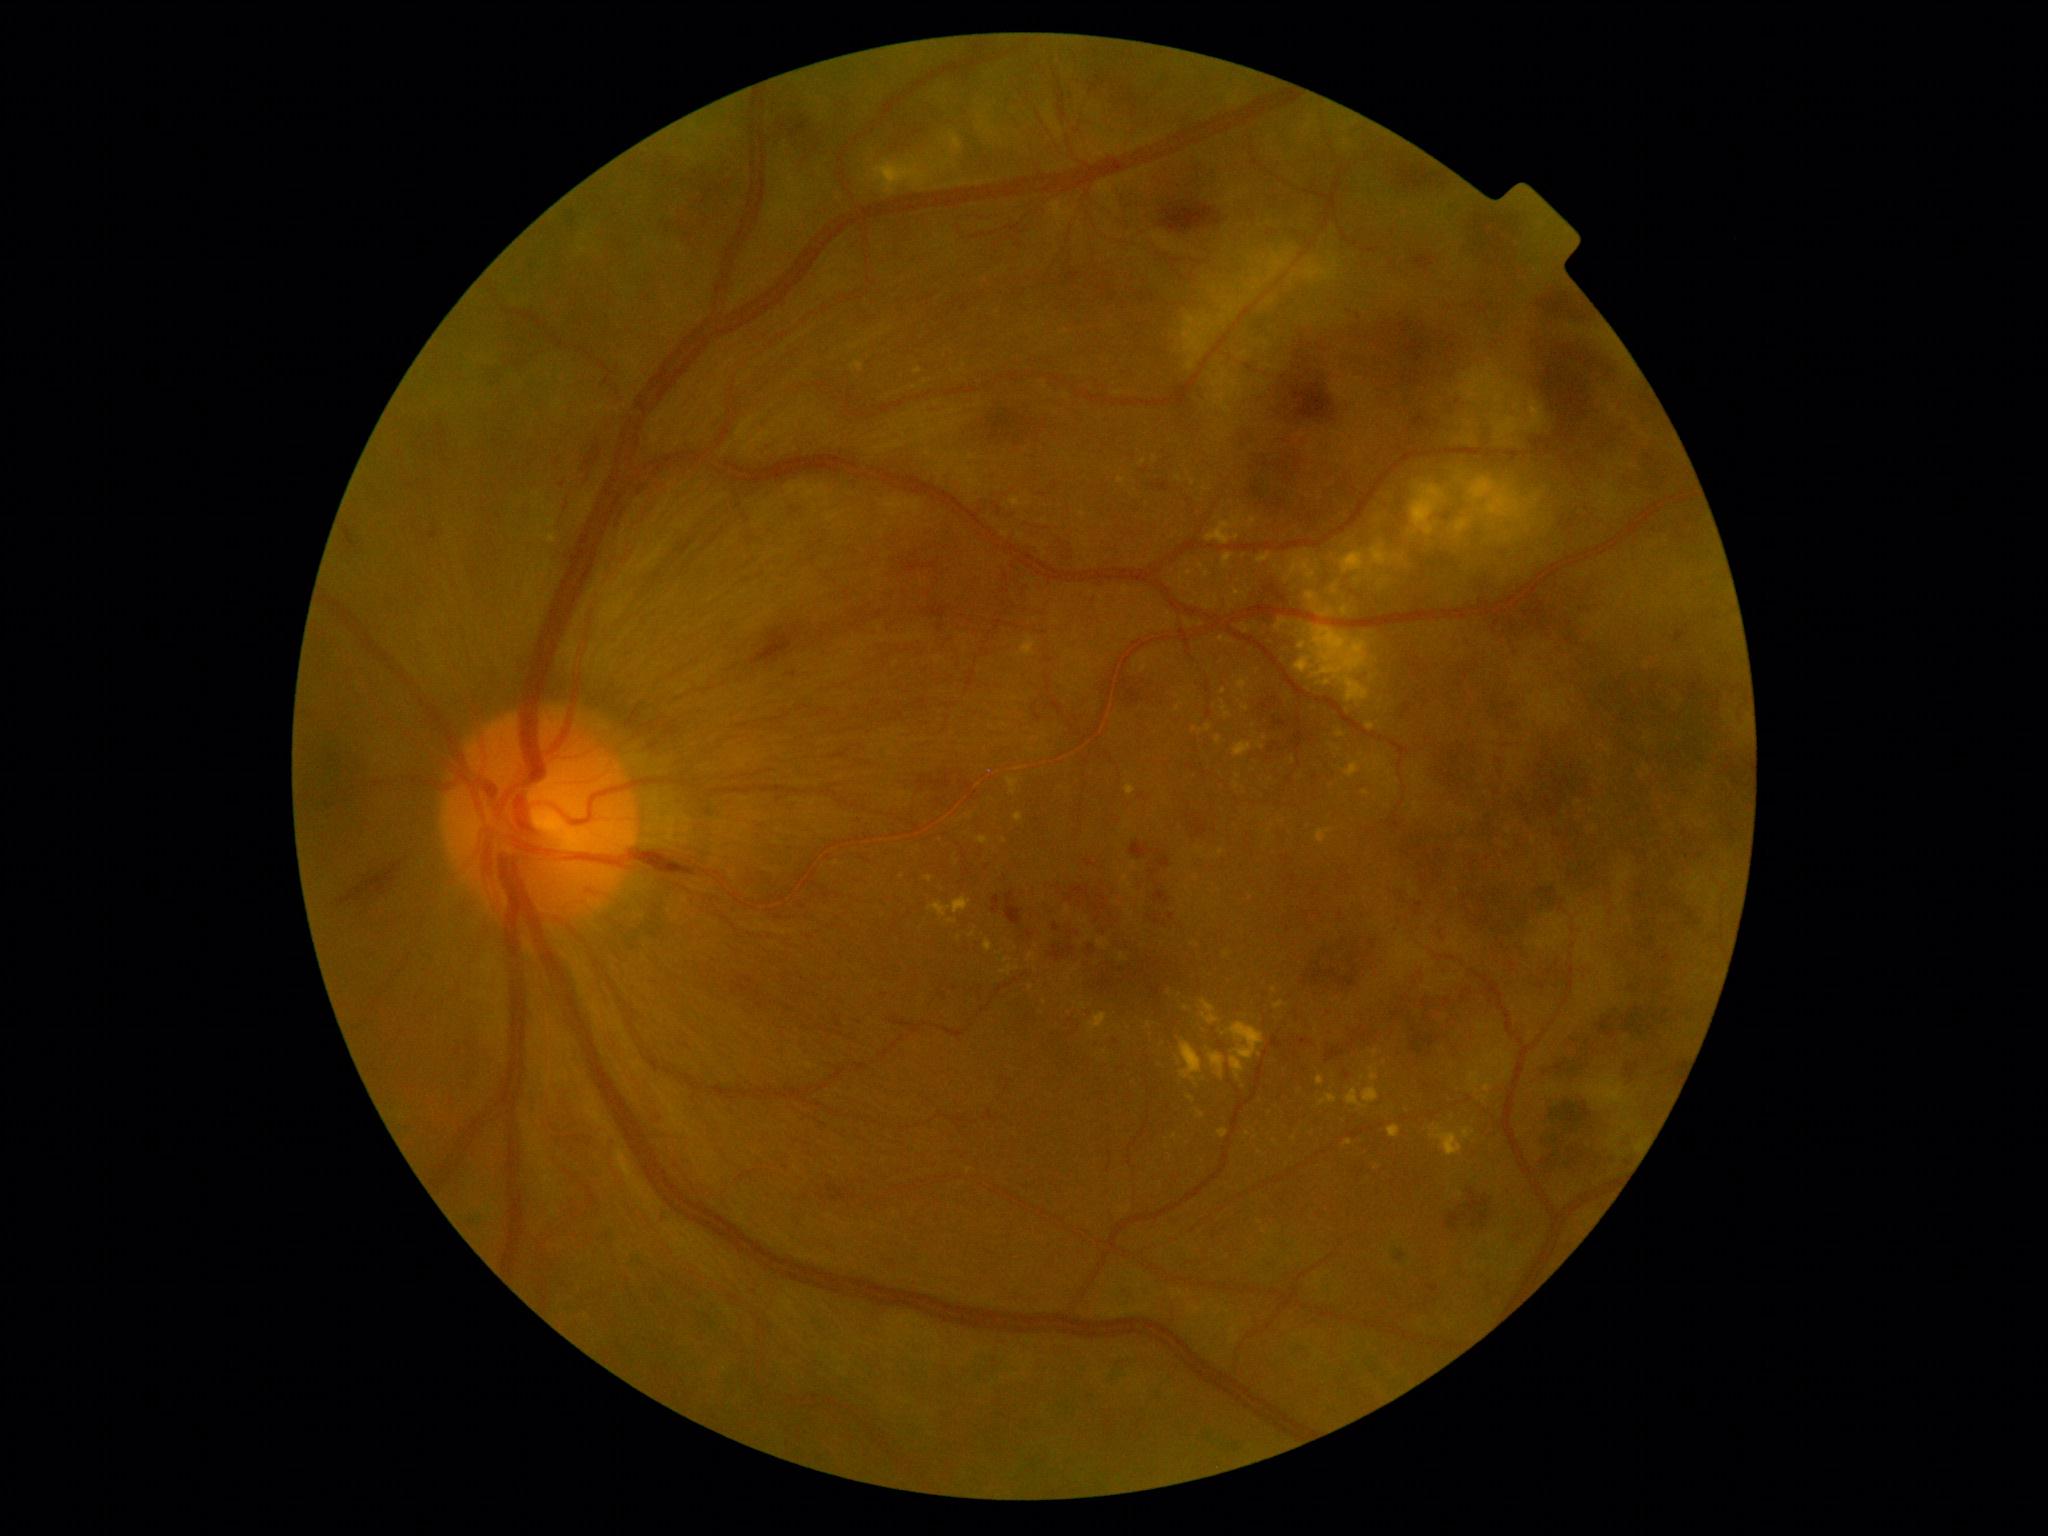

<lesions partial="true">
  <dr_grade>4</dr_grade>
  <ex partial="true">box=[1276, 619, 1286, 630], box=[1125, 785, 1137, 796], box=[1216, 736, 1223, 745], box=[1006, 777, 1019, 795], box=[873, 158, 931, 195], box=[1346, 1088, 1369, 1110], box=[1237, 677, 1248, 693], box=[1274, 1001, 1284, 1010], box=[1188, 1097, 1196, 1103]</ex>
  <ex_small_approx>Point(929, 156), Point(1316, 1032), Point(1237, 785), Point(1187, 1008), Point(1190, 573), Point(1135, 664), Point(1006, 961), Point(968, 817)</ex_small_approx>
</lesions>